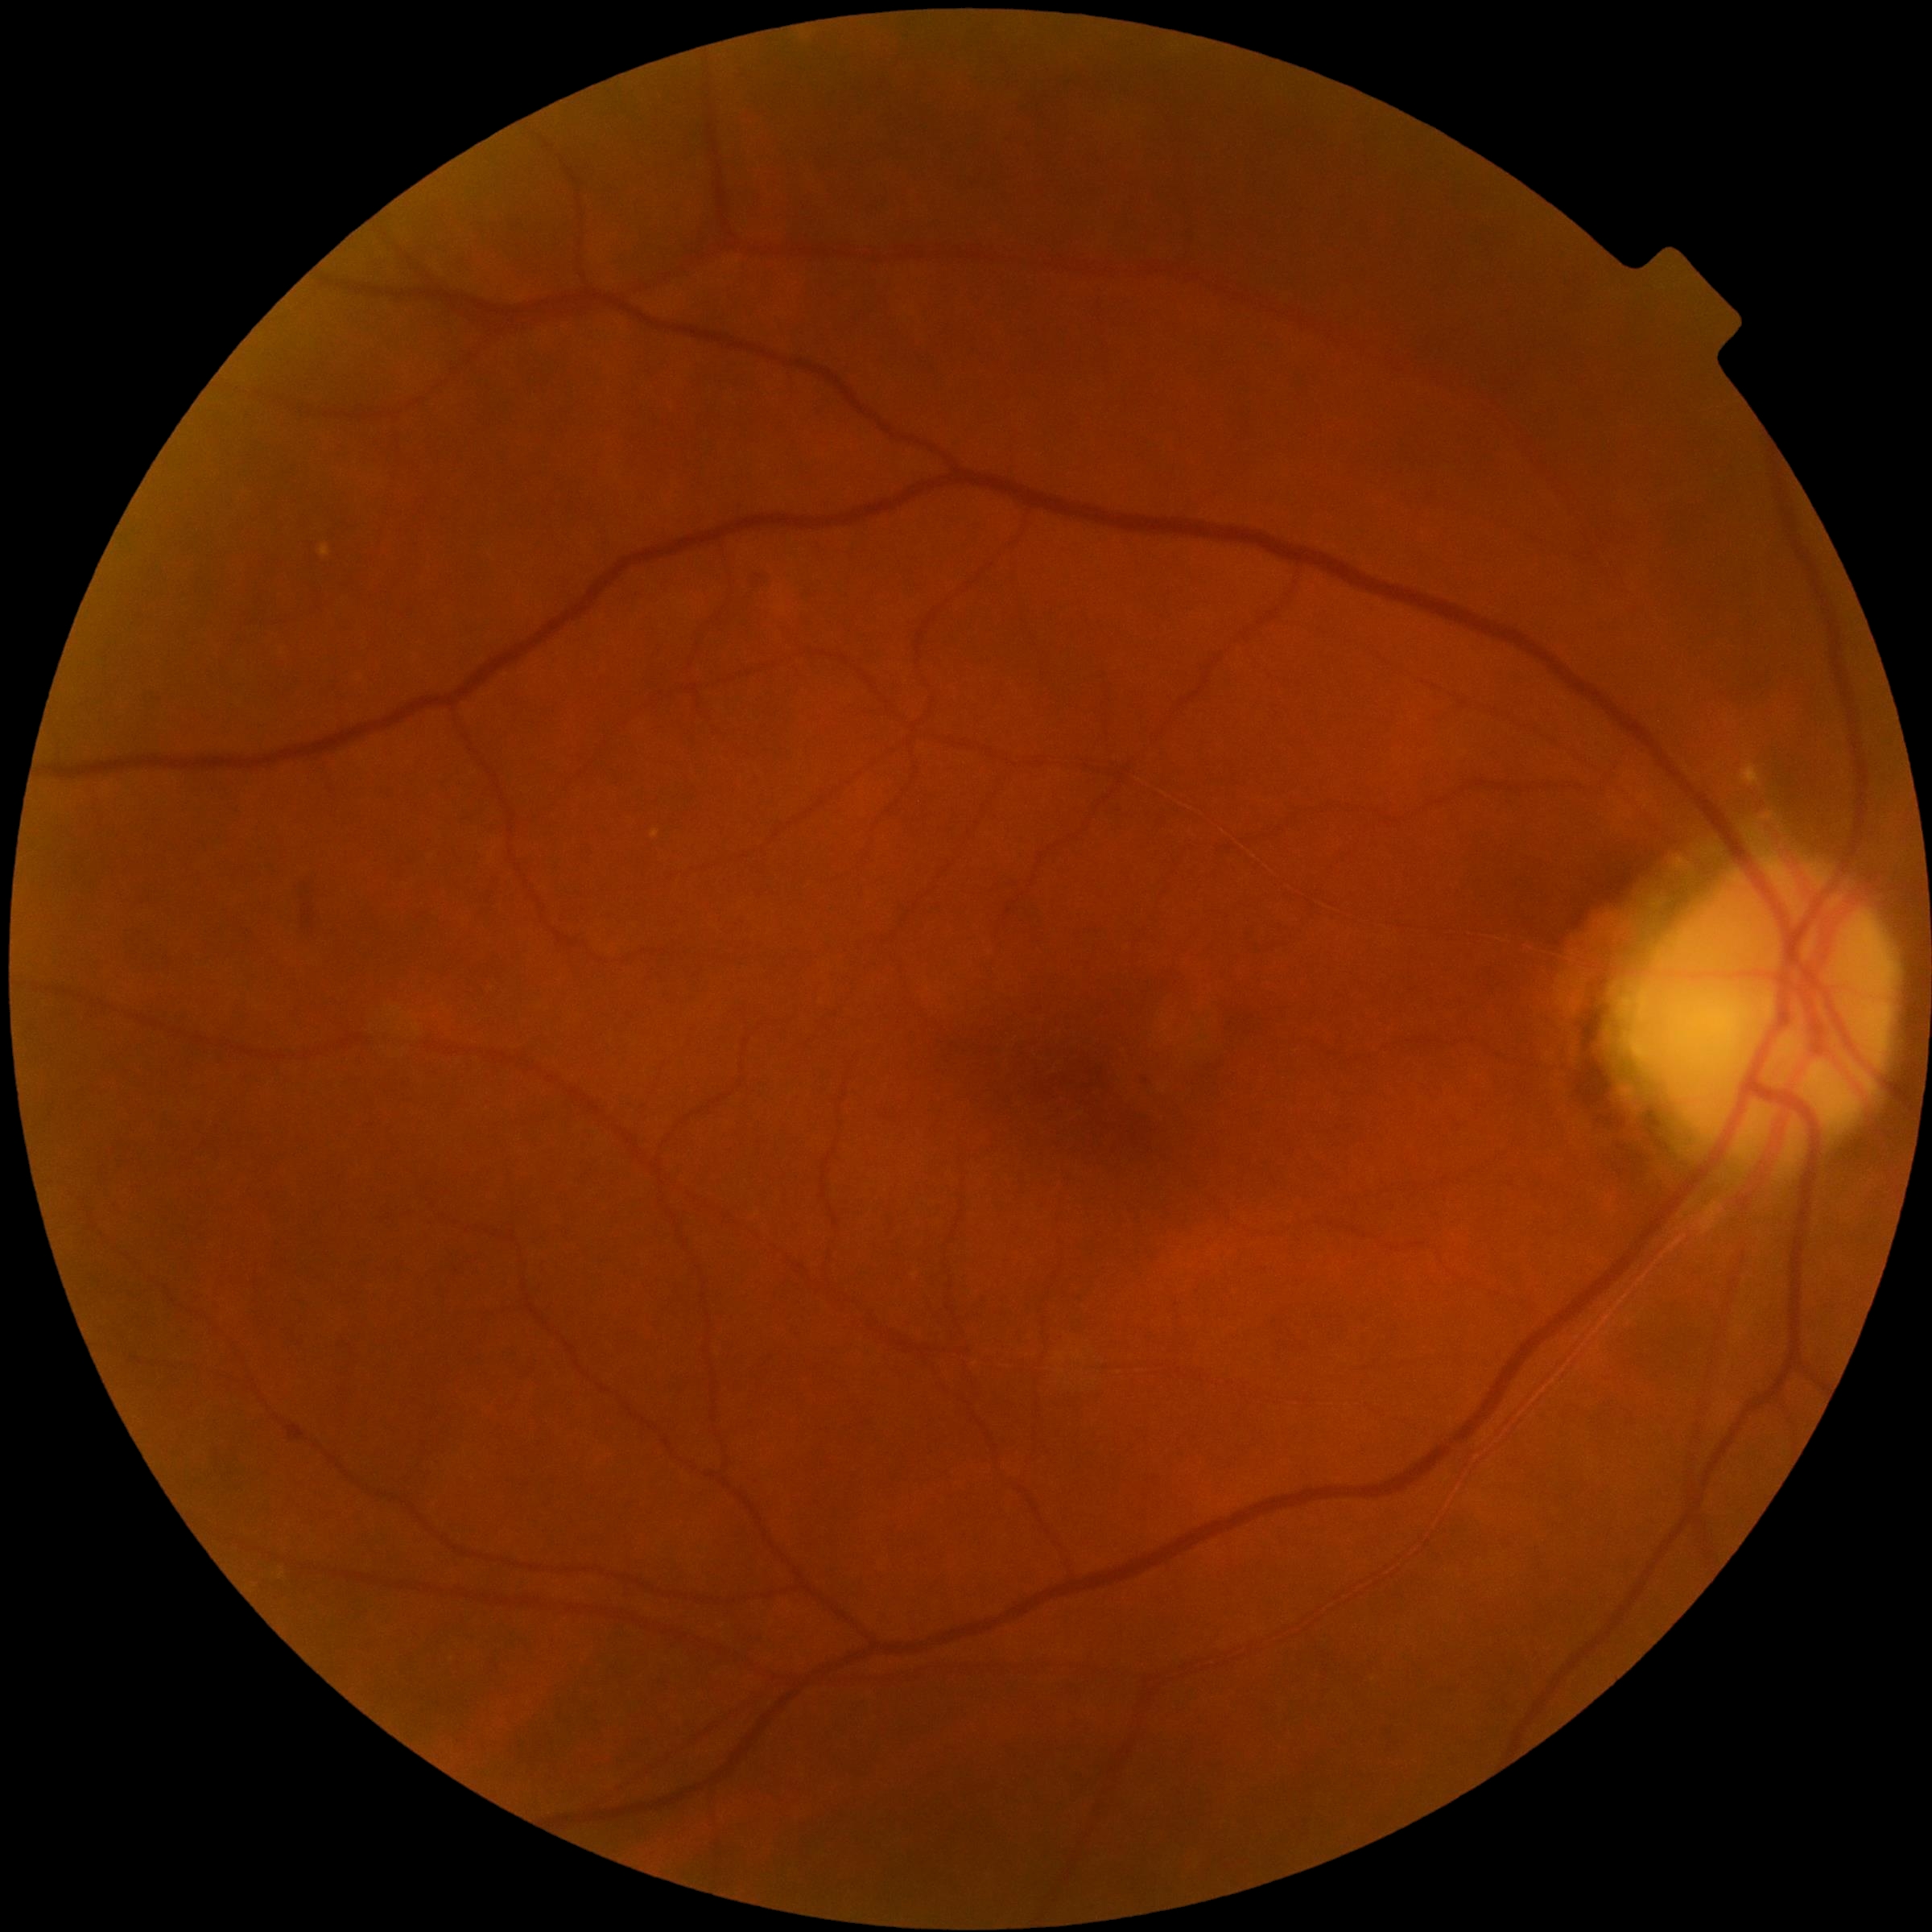

DR stage: no apparent diabetic retinopathy (grade 0).